45° field of view; Davis DR grading:
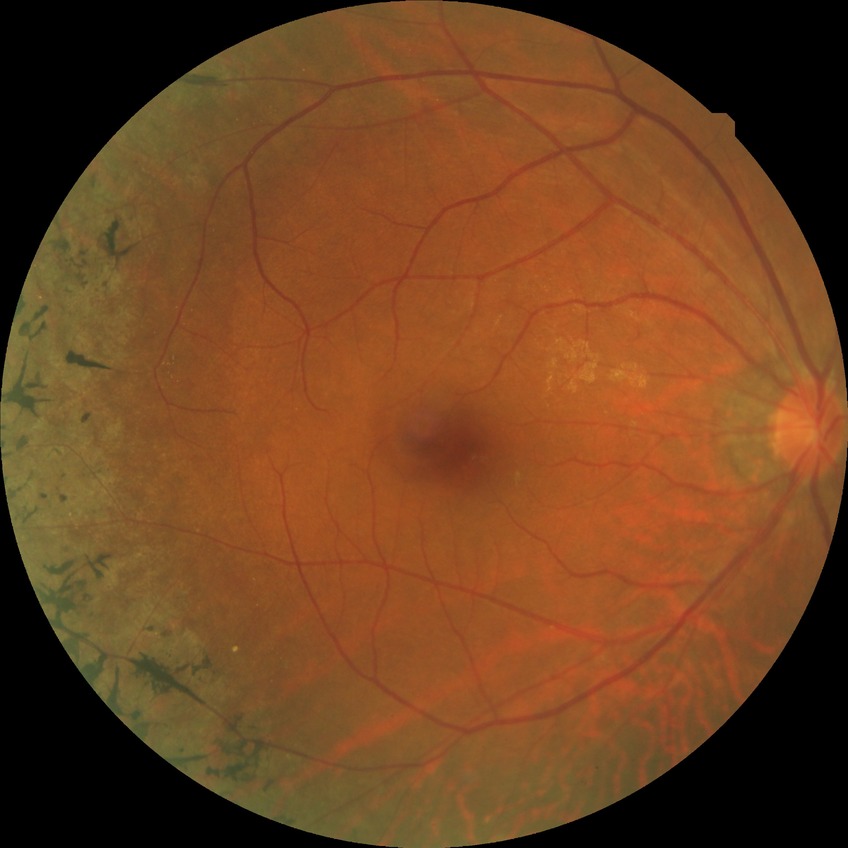
Diabetic retinopathy (DR) is NDR (no diabetic retinopathy).